45° FOV
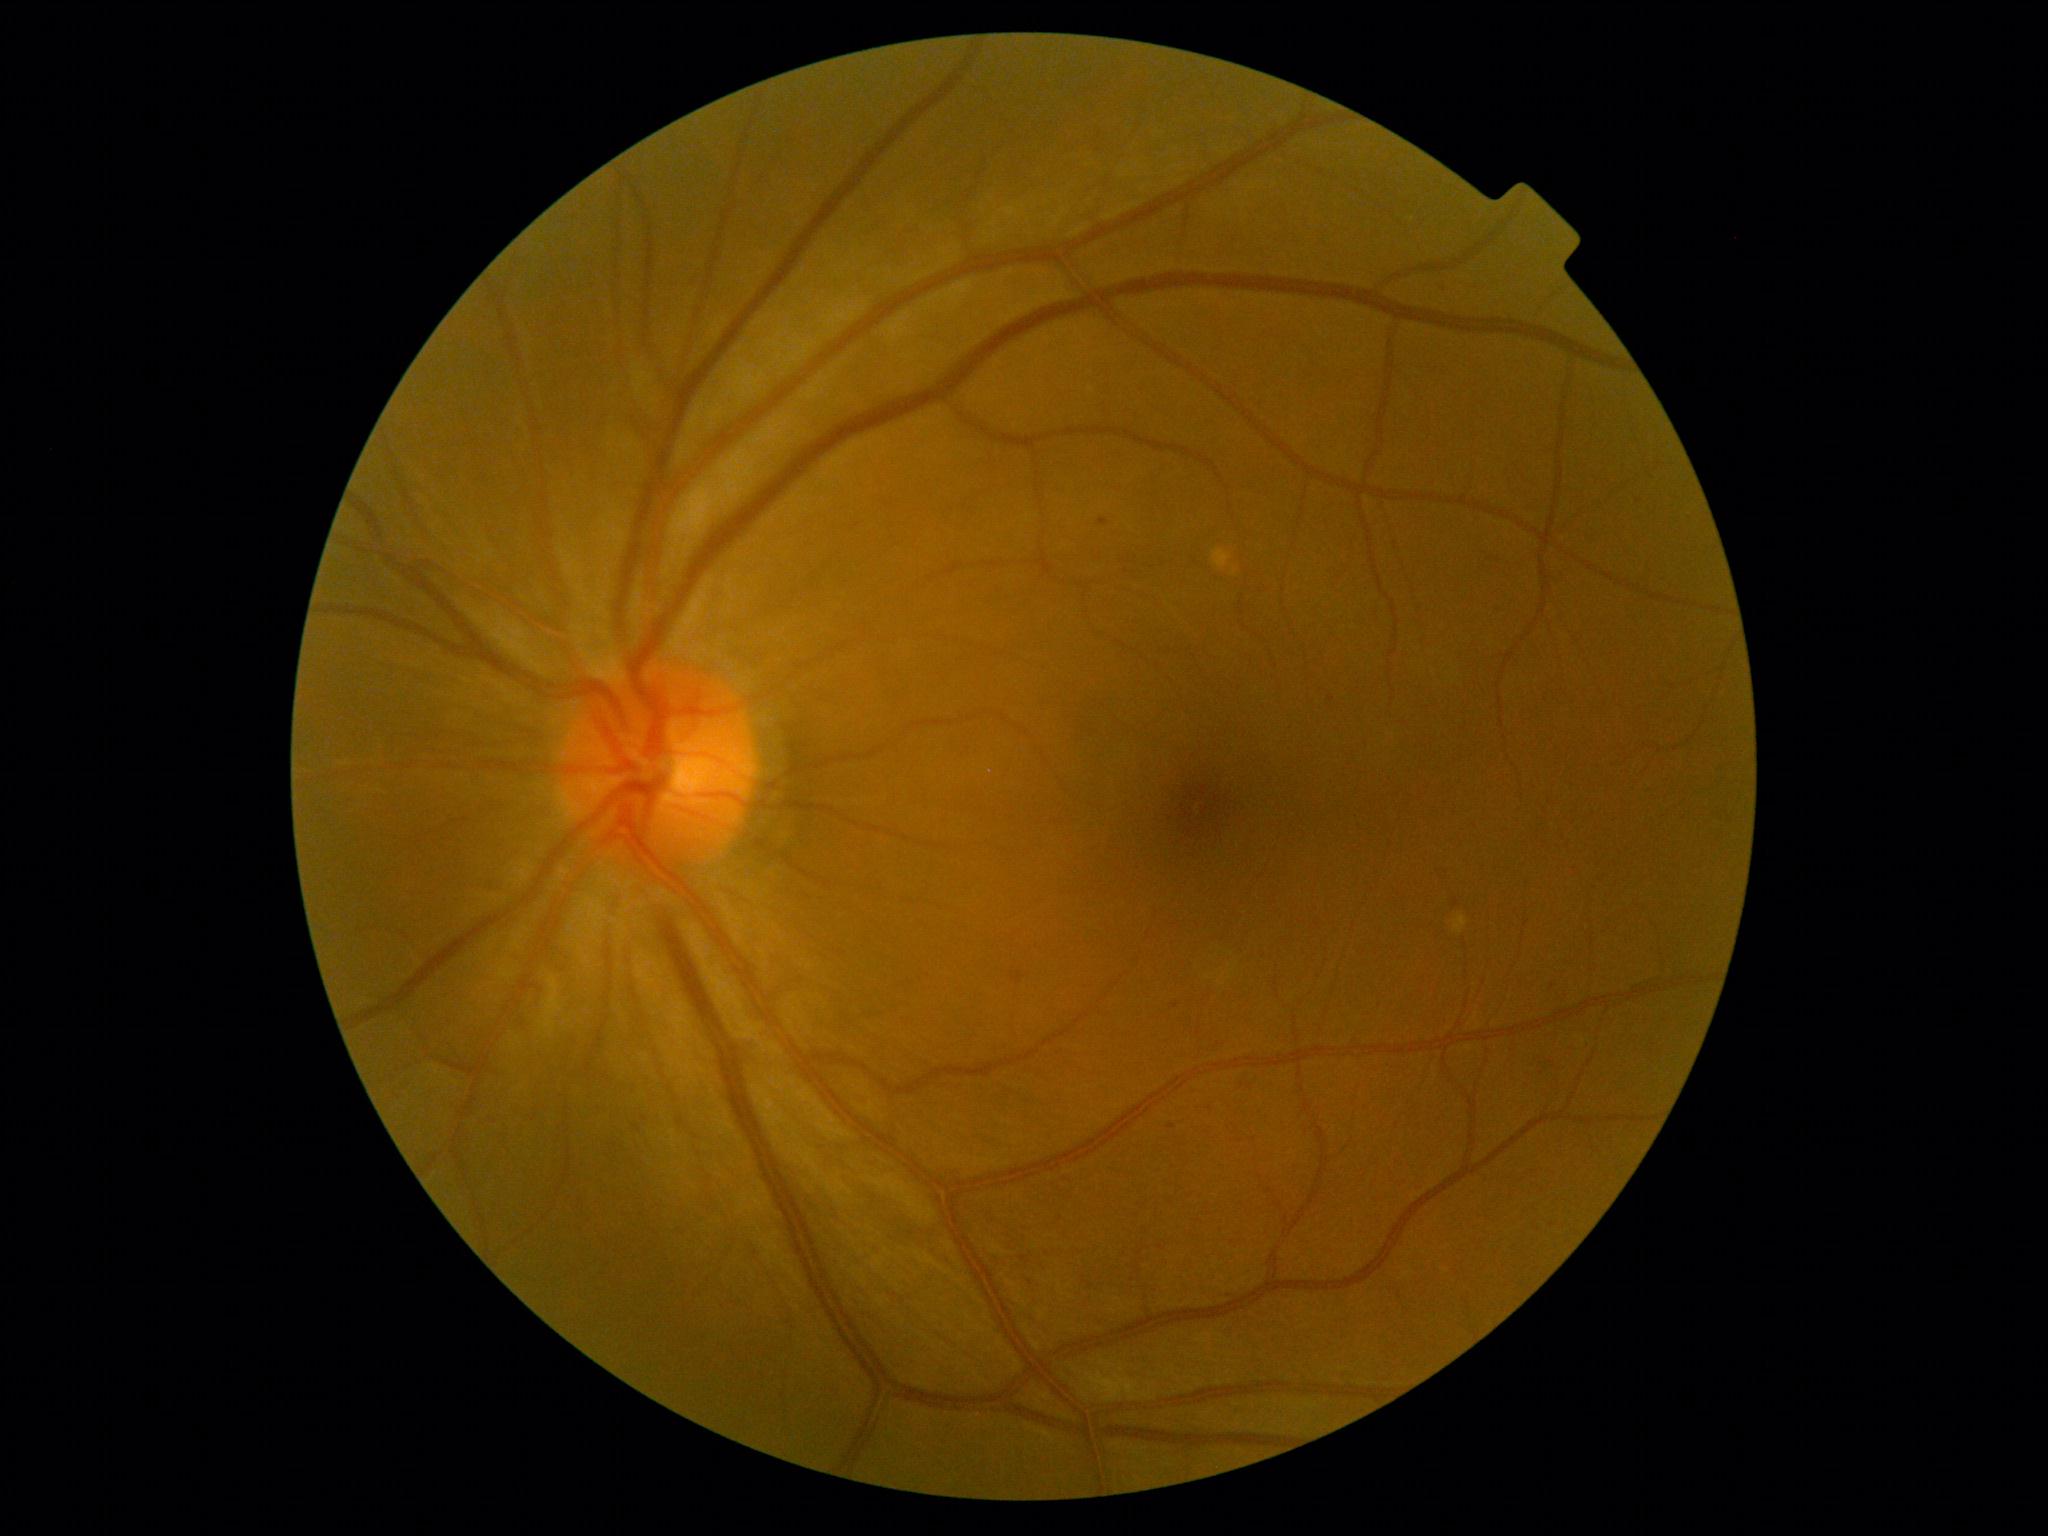

Retinopathy: grade 1 (mild NPDR). No hemorrhages identified. No hard exudates identified. Microaneurysms present at (left=1013, top=973, right=1023, bottom=984), (left=1099, top=519, right=1109, bottom=527). Microaneurysms (small, approximate centers) near point(1332, 700), point(1172, 1127), point(1639, 502), point(1177, 1006). No soft exudates identified.